Optic disc-centered crop from a color fundus photograph. 35° field of view before cropping. Mydriatic:
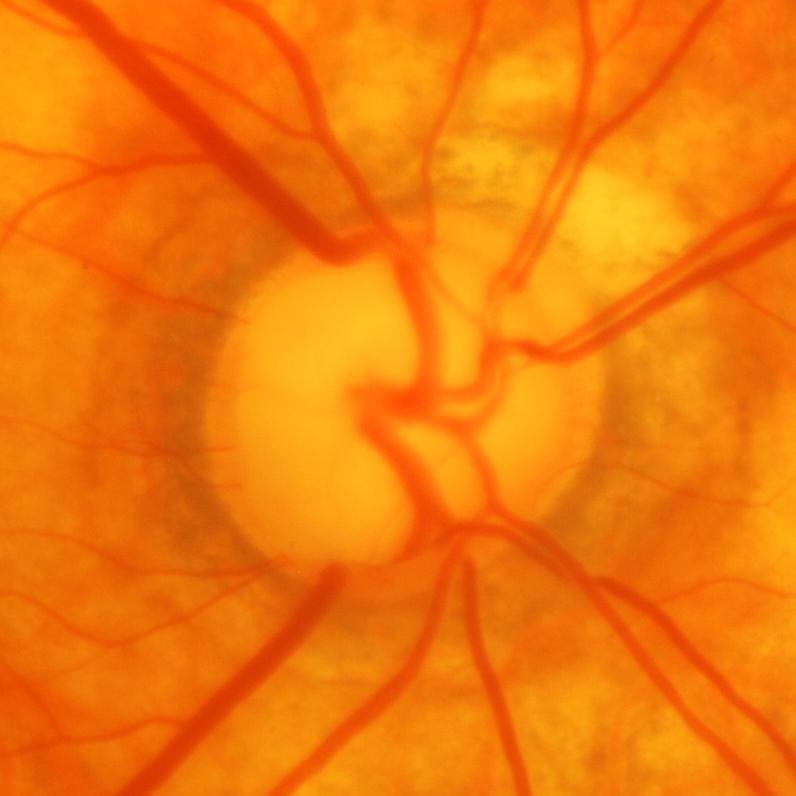 Q: Is there glaucomatous optic neuropathy?
A: Glaucoma.